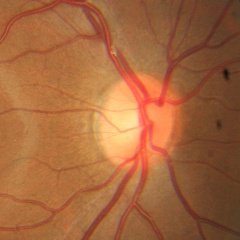 Optic disc appearance consistent with no glaucomatous findings.